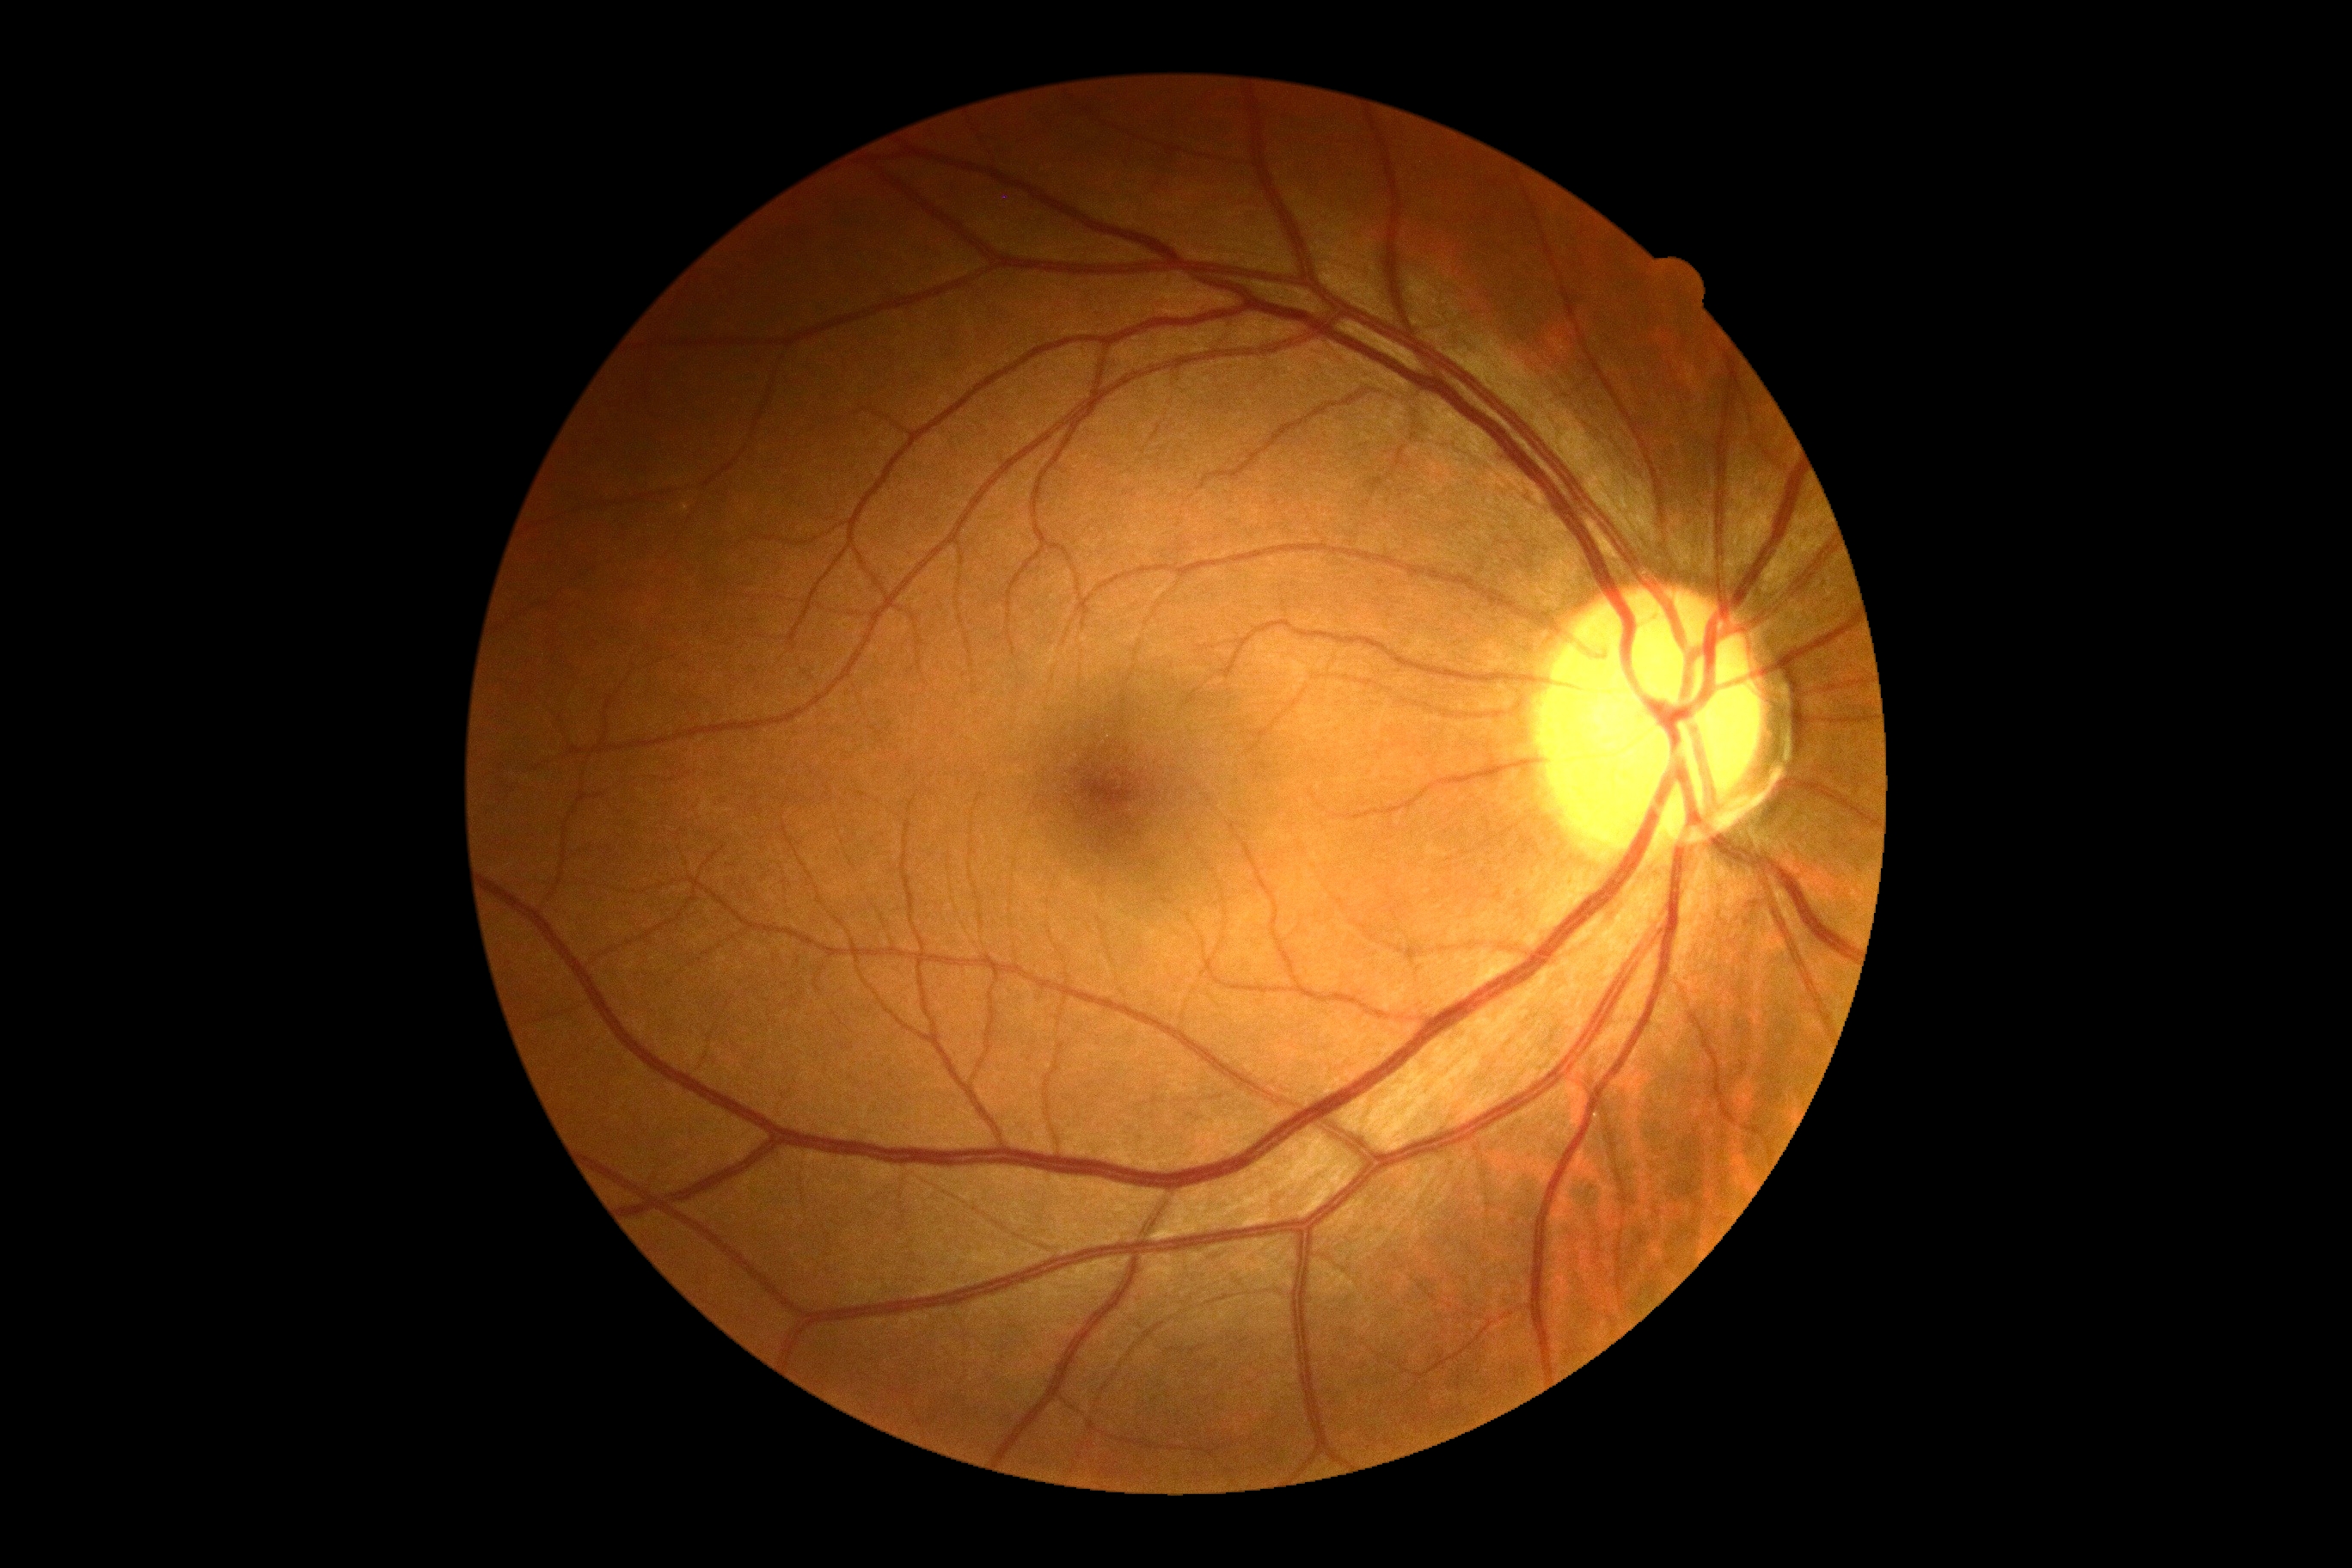 DR: grade 0.